45° FOV
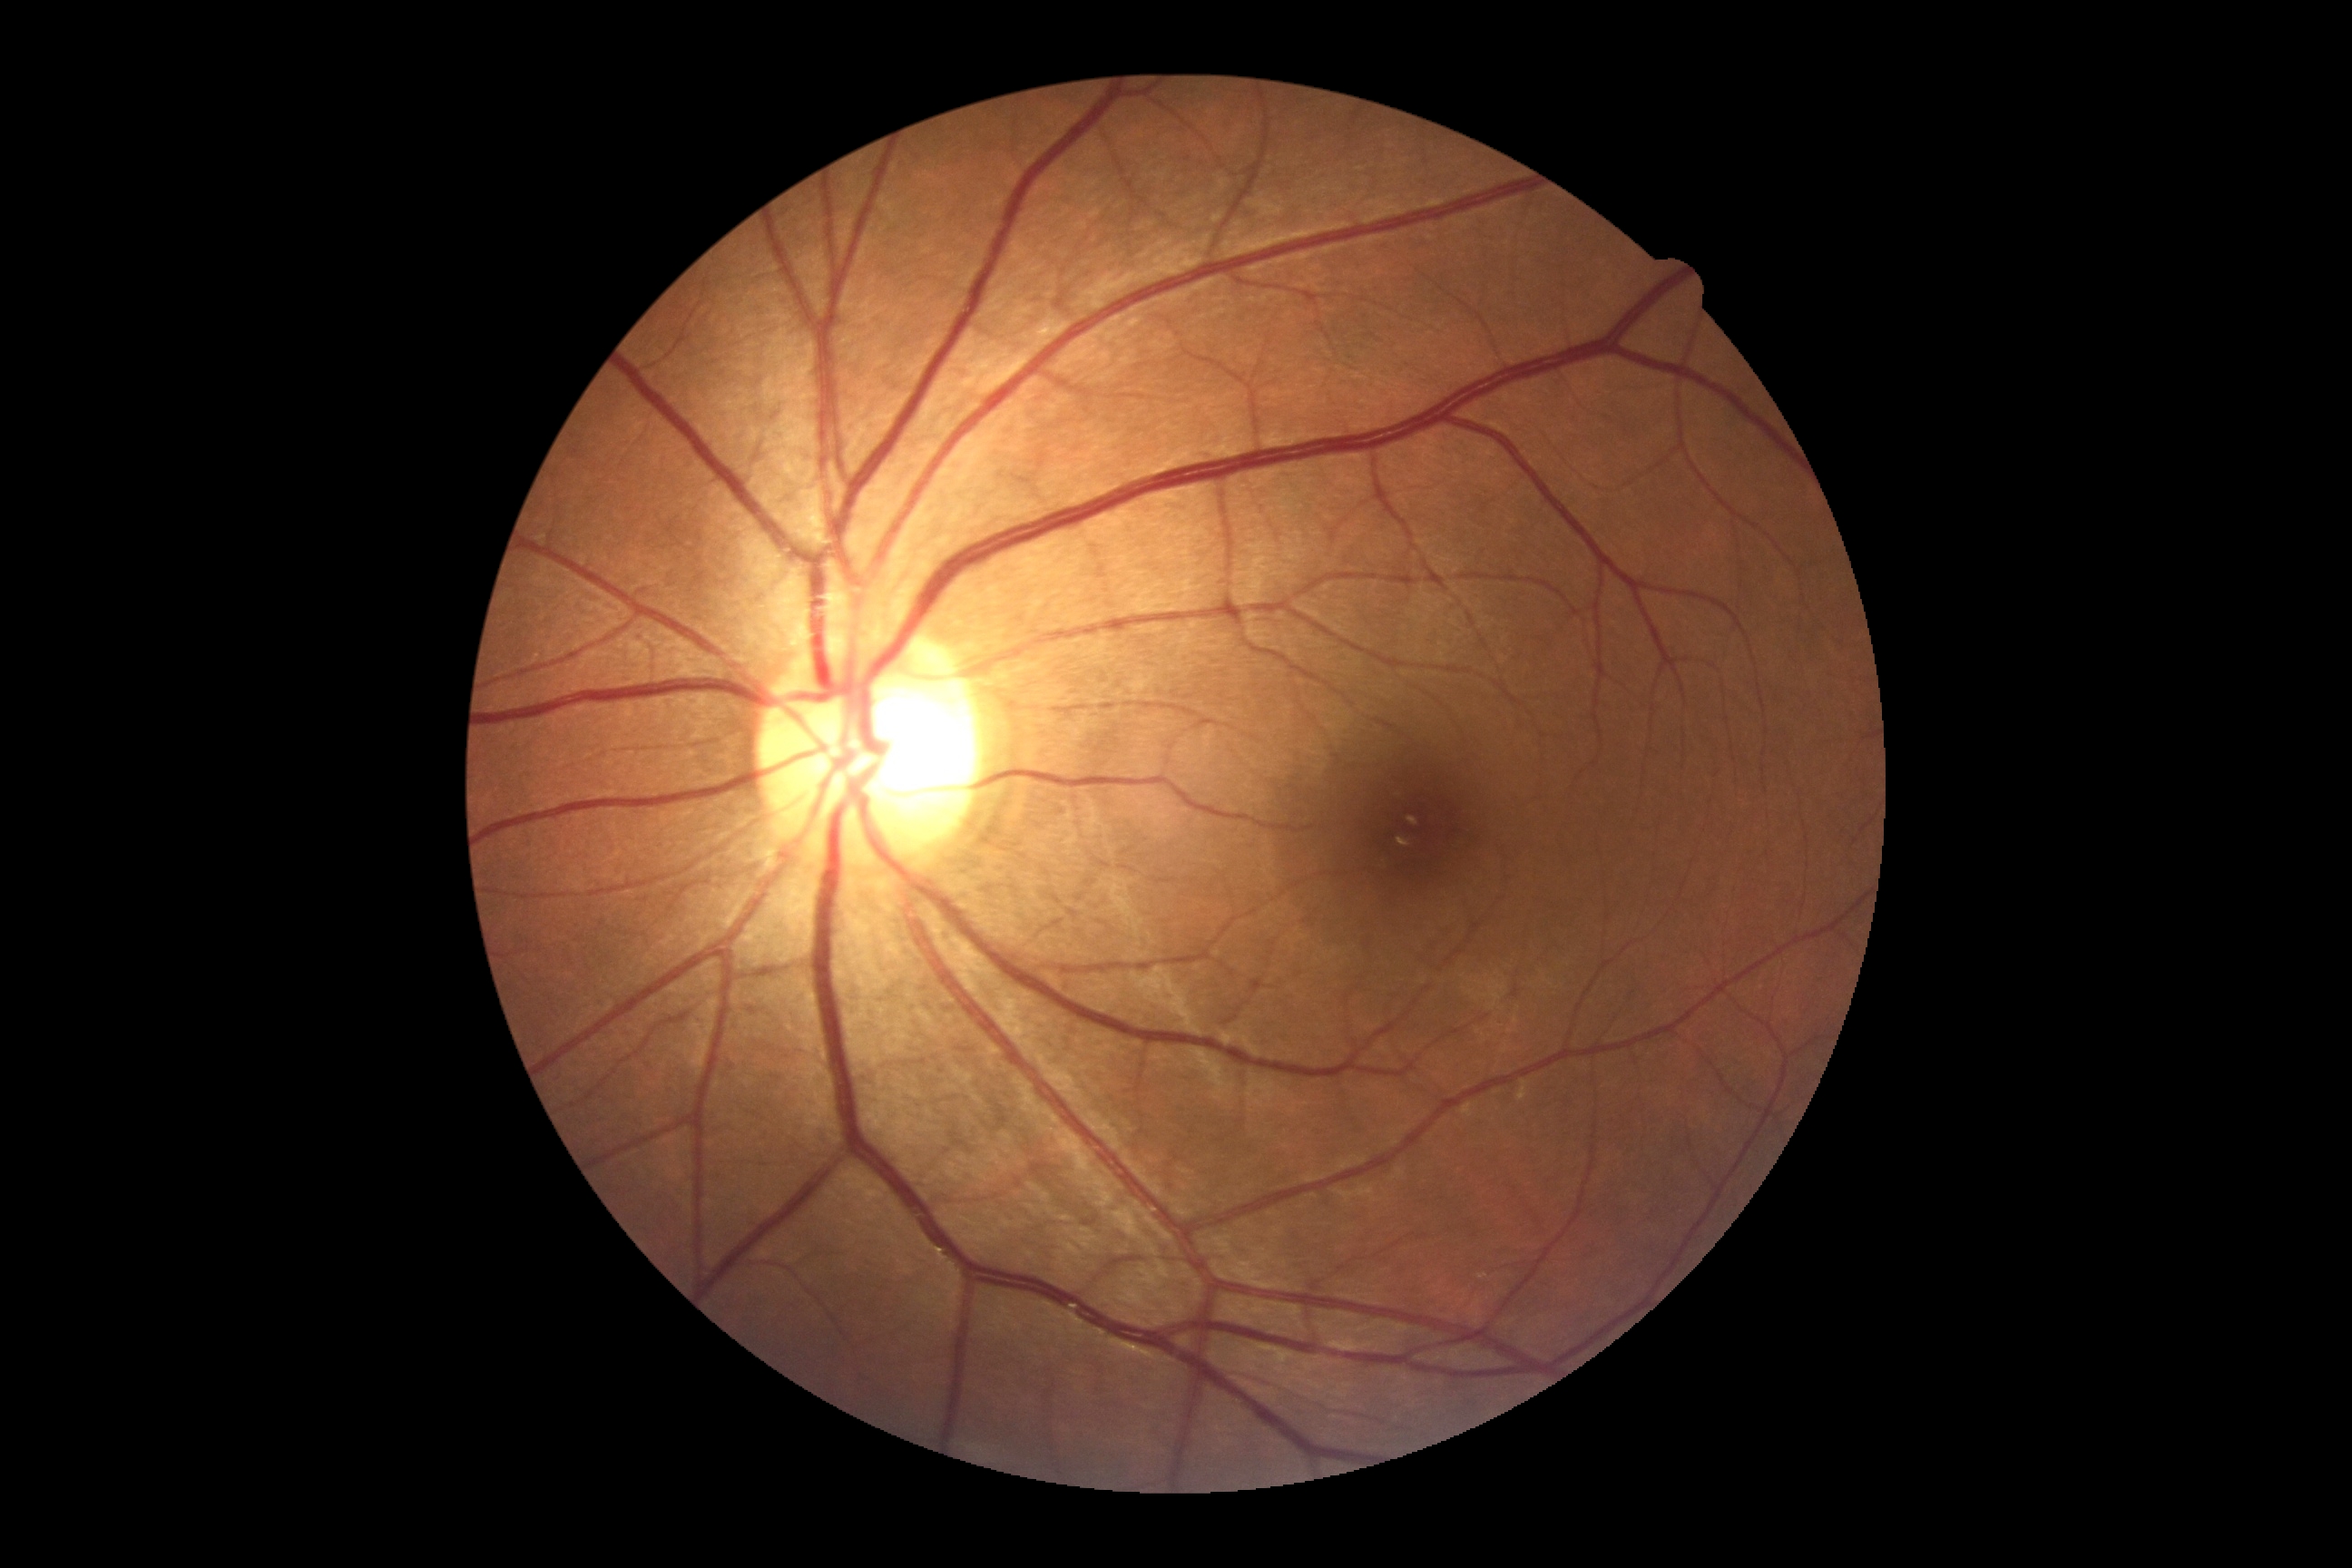
{"dr_grade": "no apparent retinopathy (grade 0)"}